Image size 1380x1382; color fundus photograph:
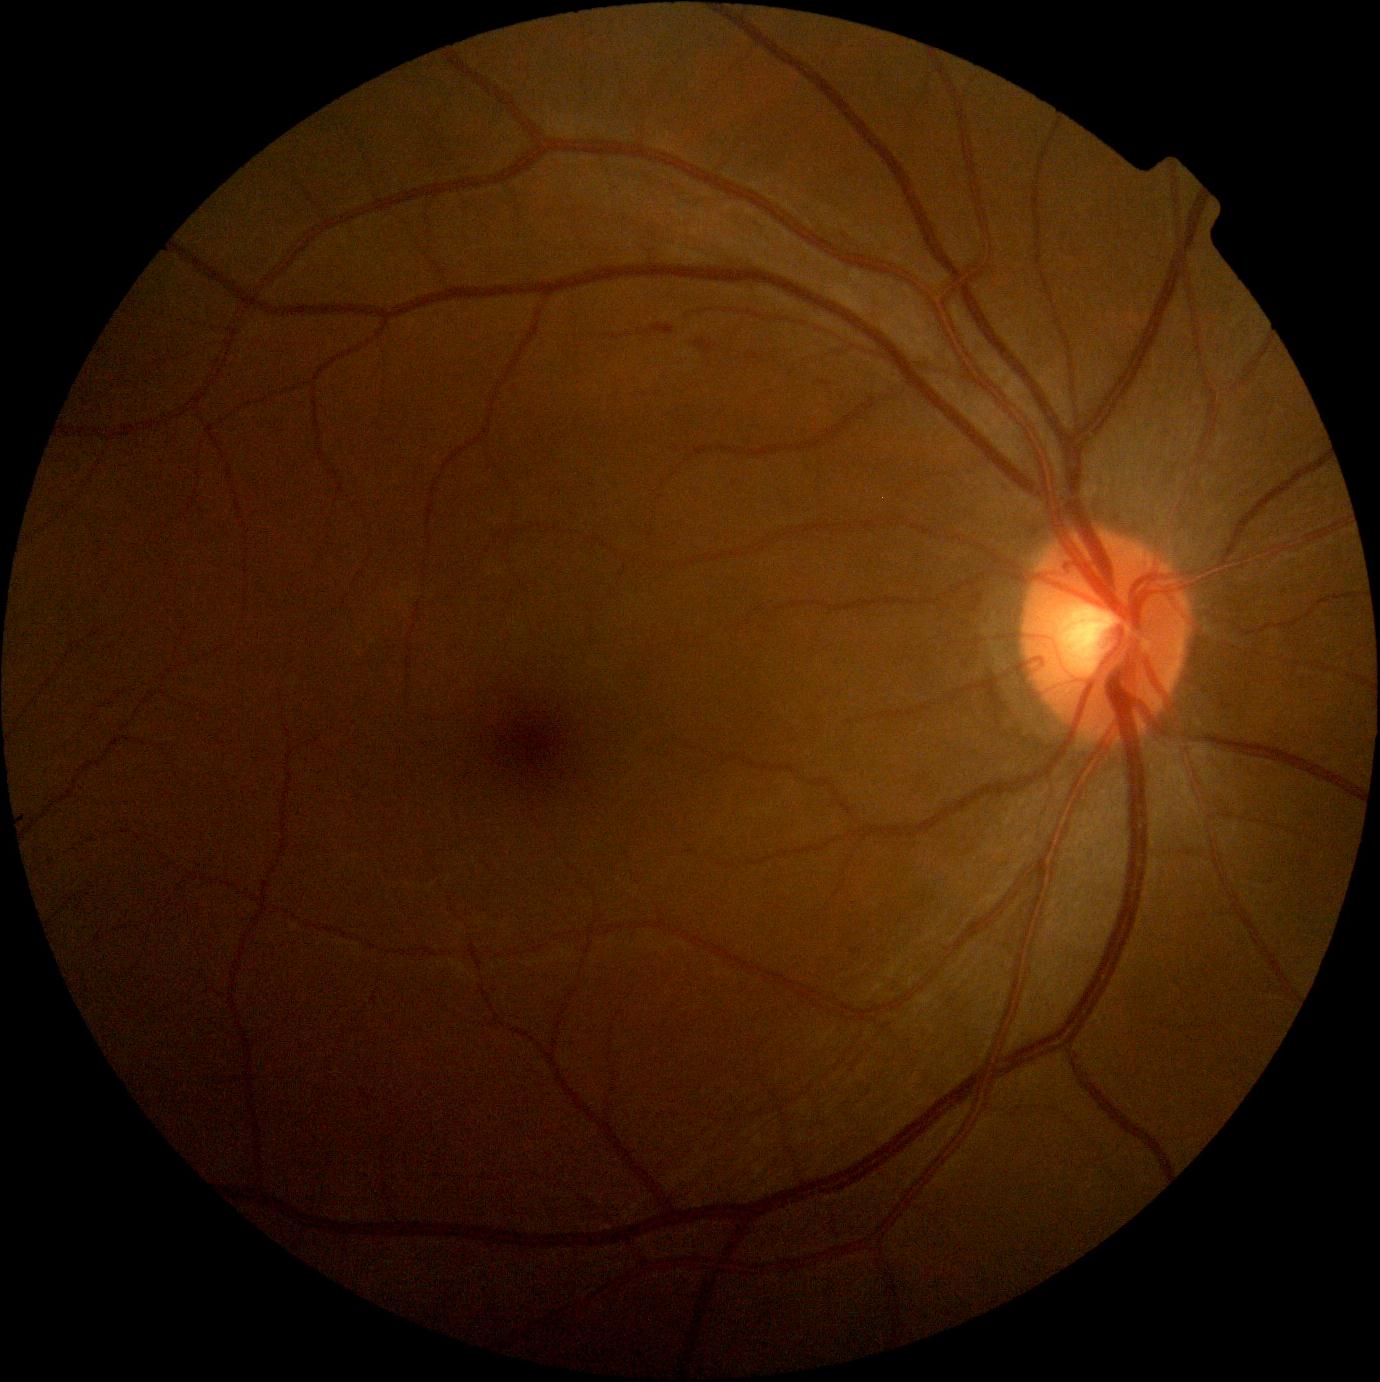
DR severity: 1.